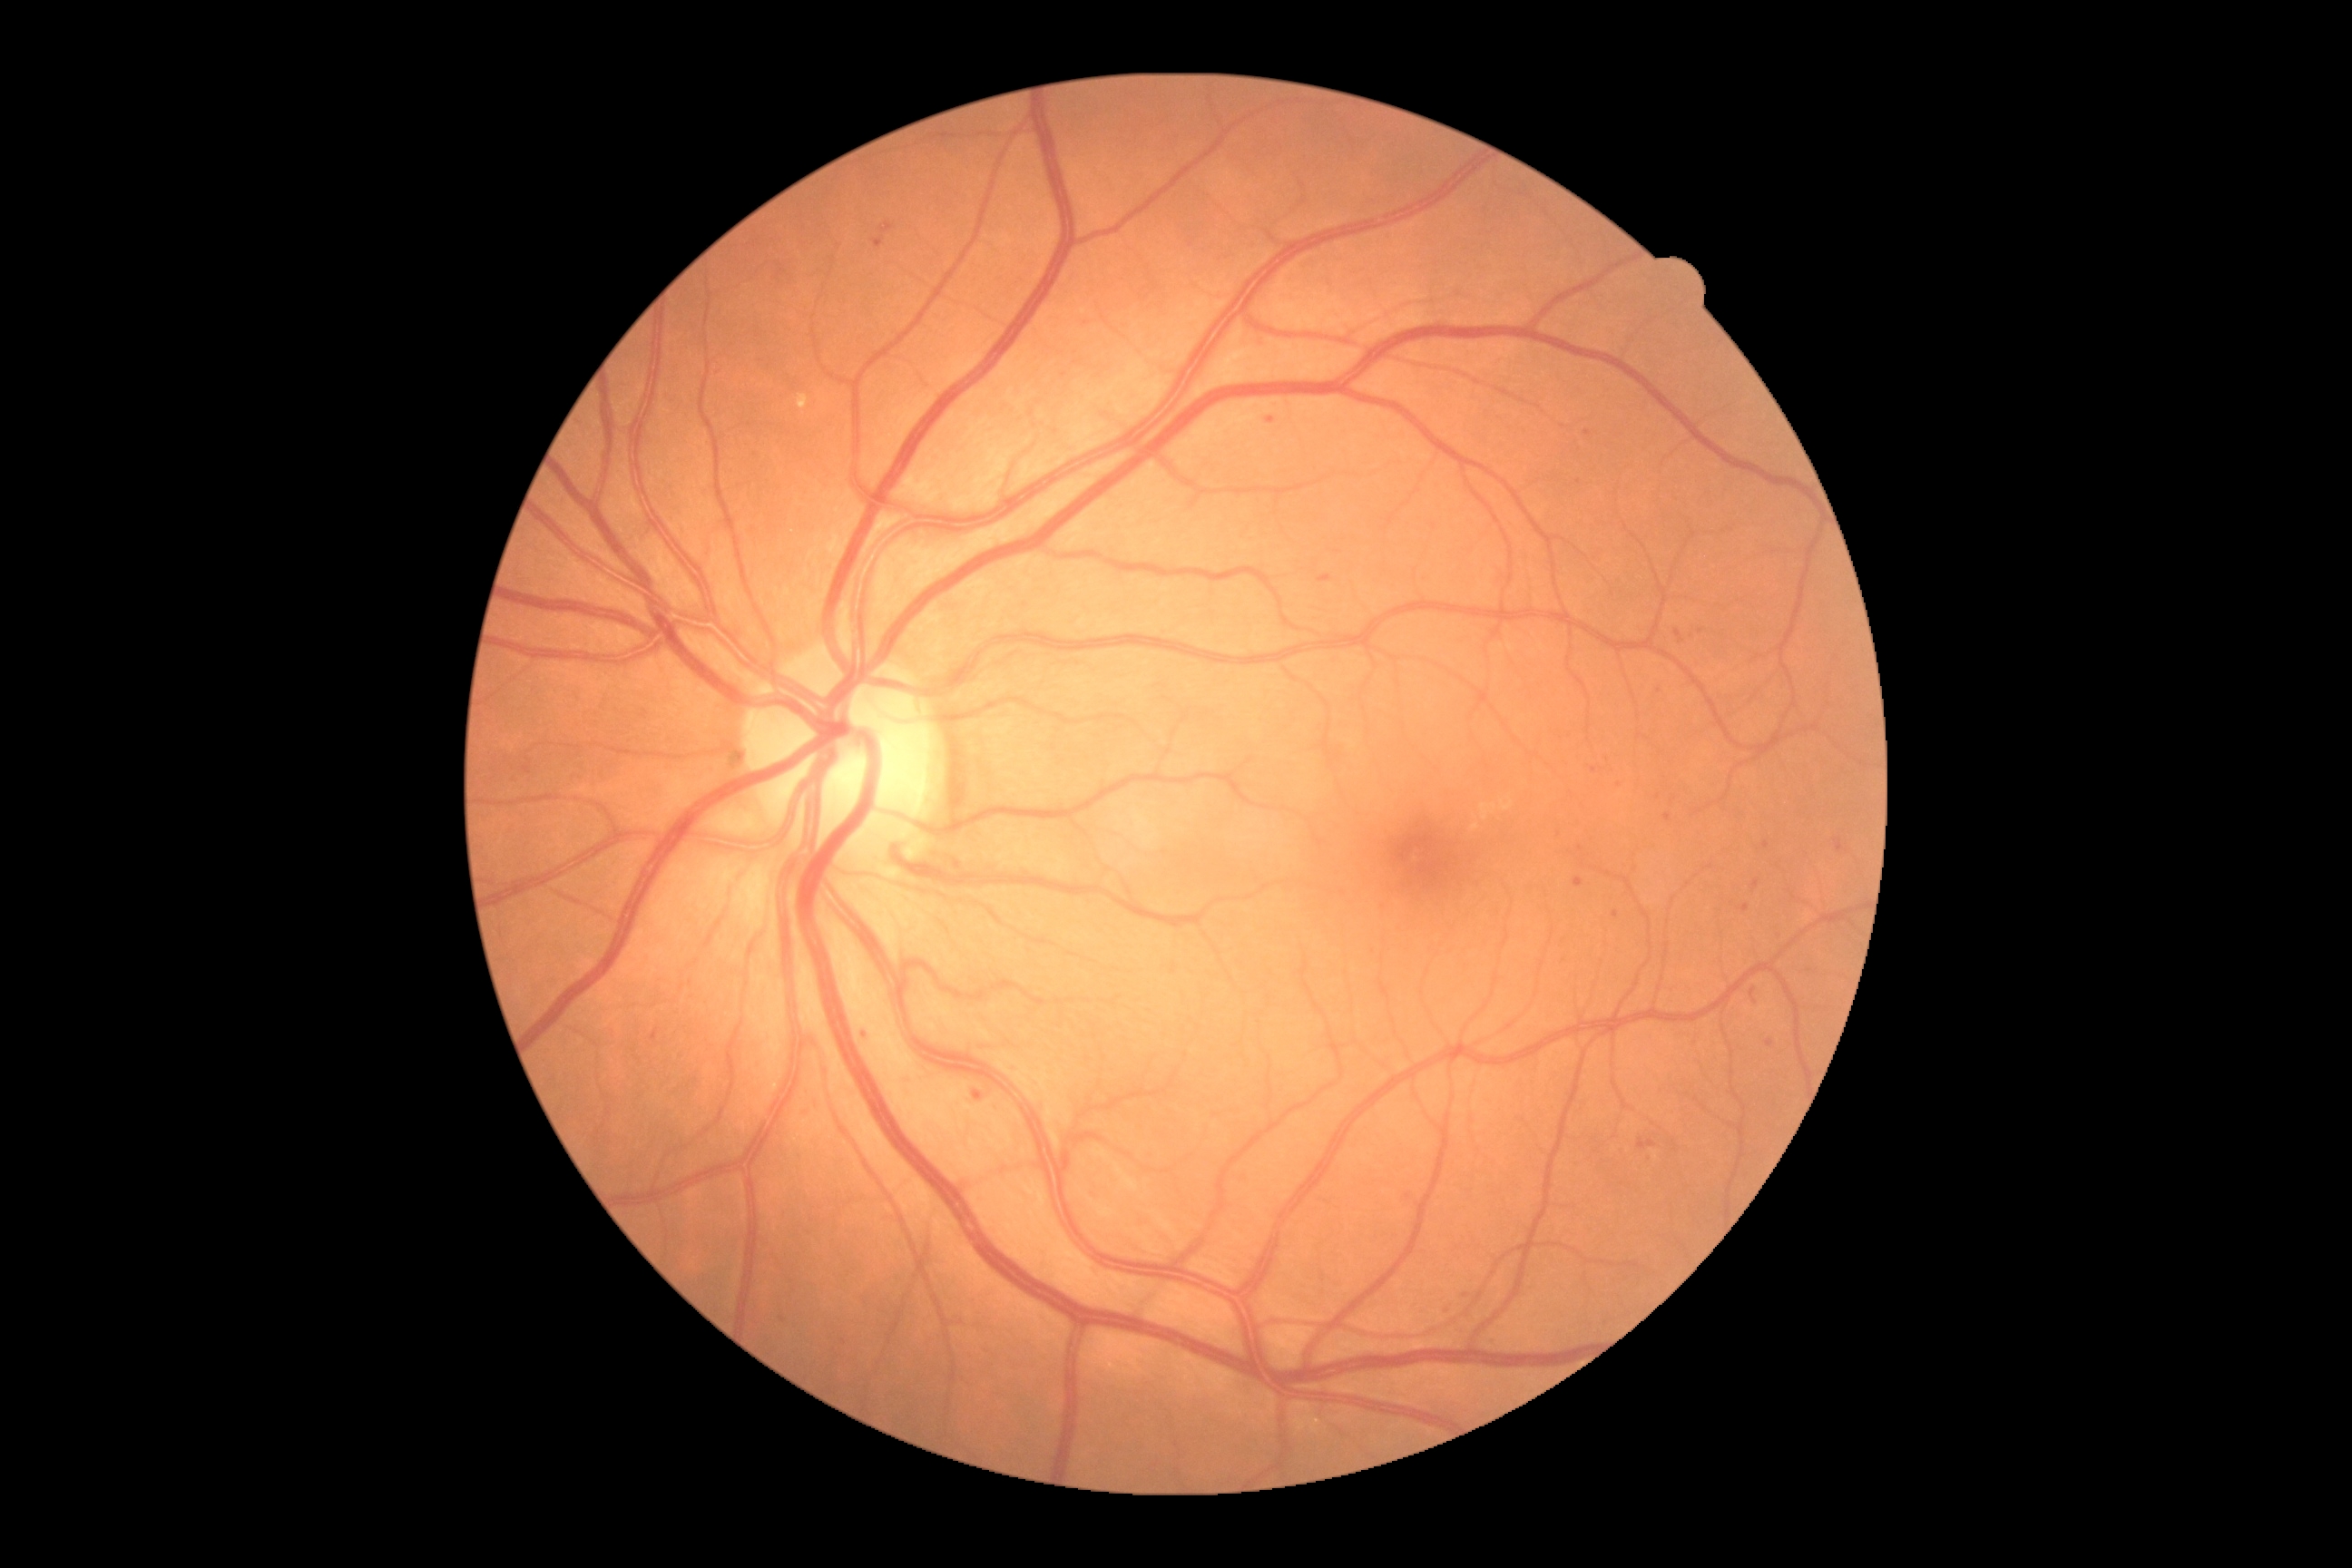 Diabetic retinopathy (DR) is 2. Microaneurysms (MAs) (partial list) at 651:1035:660:1041 | 974:1090:983:1101 | 1640:1135:1647:1148 | 1654:1139:1660:1148 | 1743:905:1749:914. MAs (small, approximate centers) near [1625,1149] | [1588,432] | [1668,817] | [1766,845] | [1447,1311] | [1272,421] | [1580,849] | [1842,848] | [1658,798].